Phoenix ICON, 100° FOV; wide-field fundus image from infant ROP screening
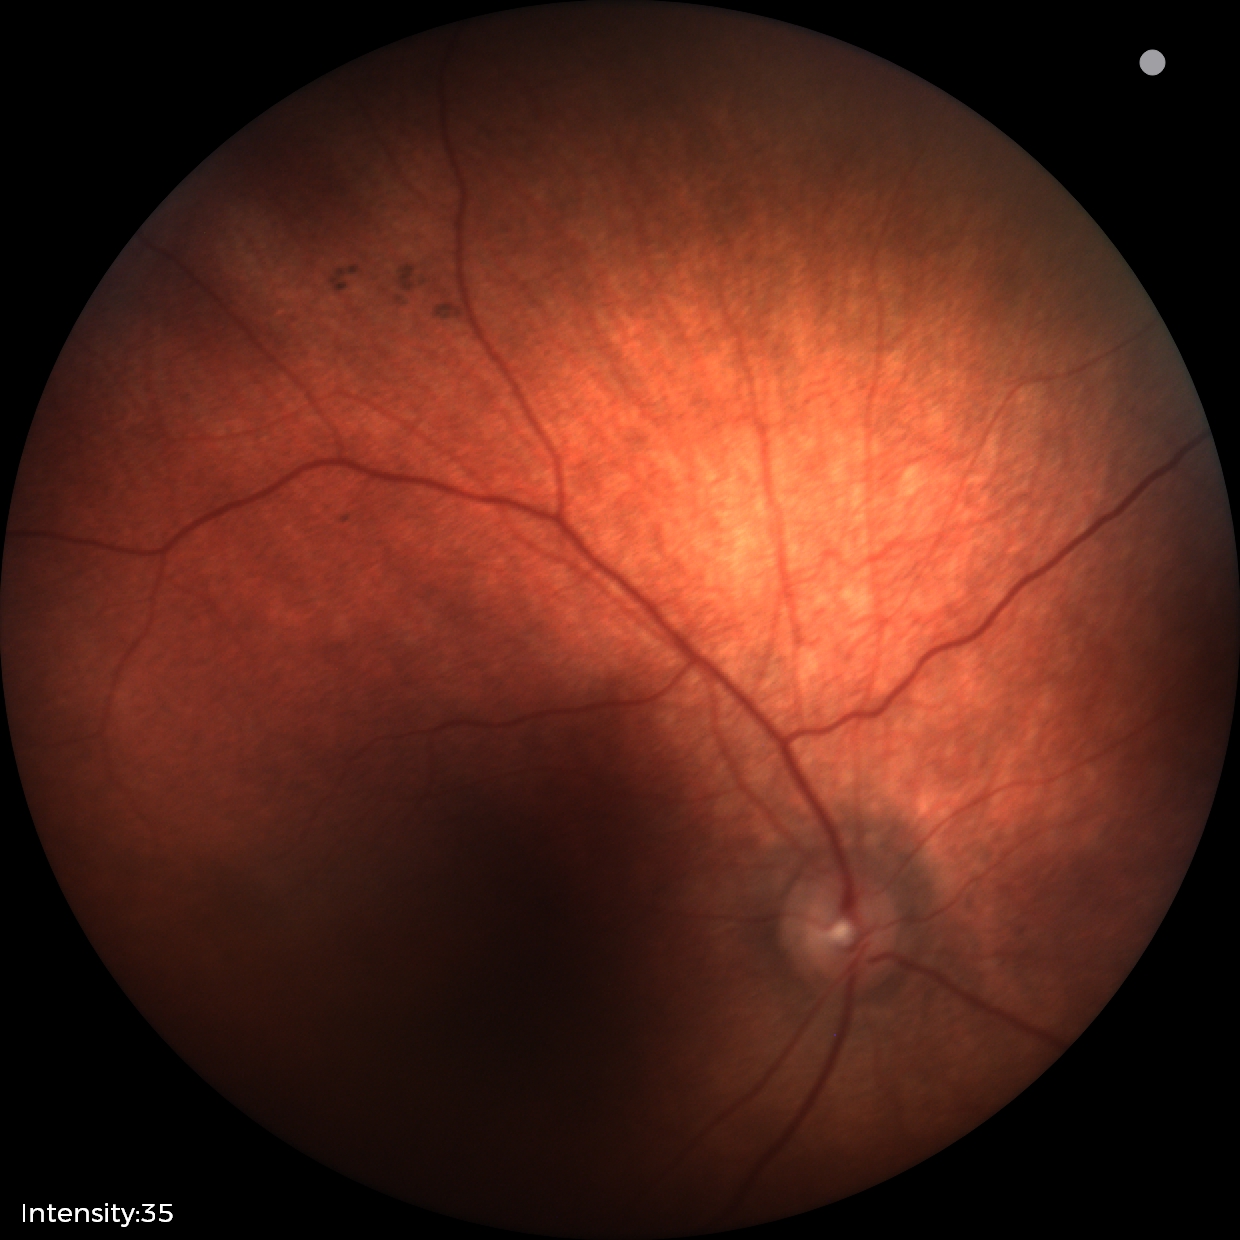 Physiological retinal appearance for postconceptual age.